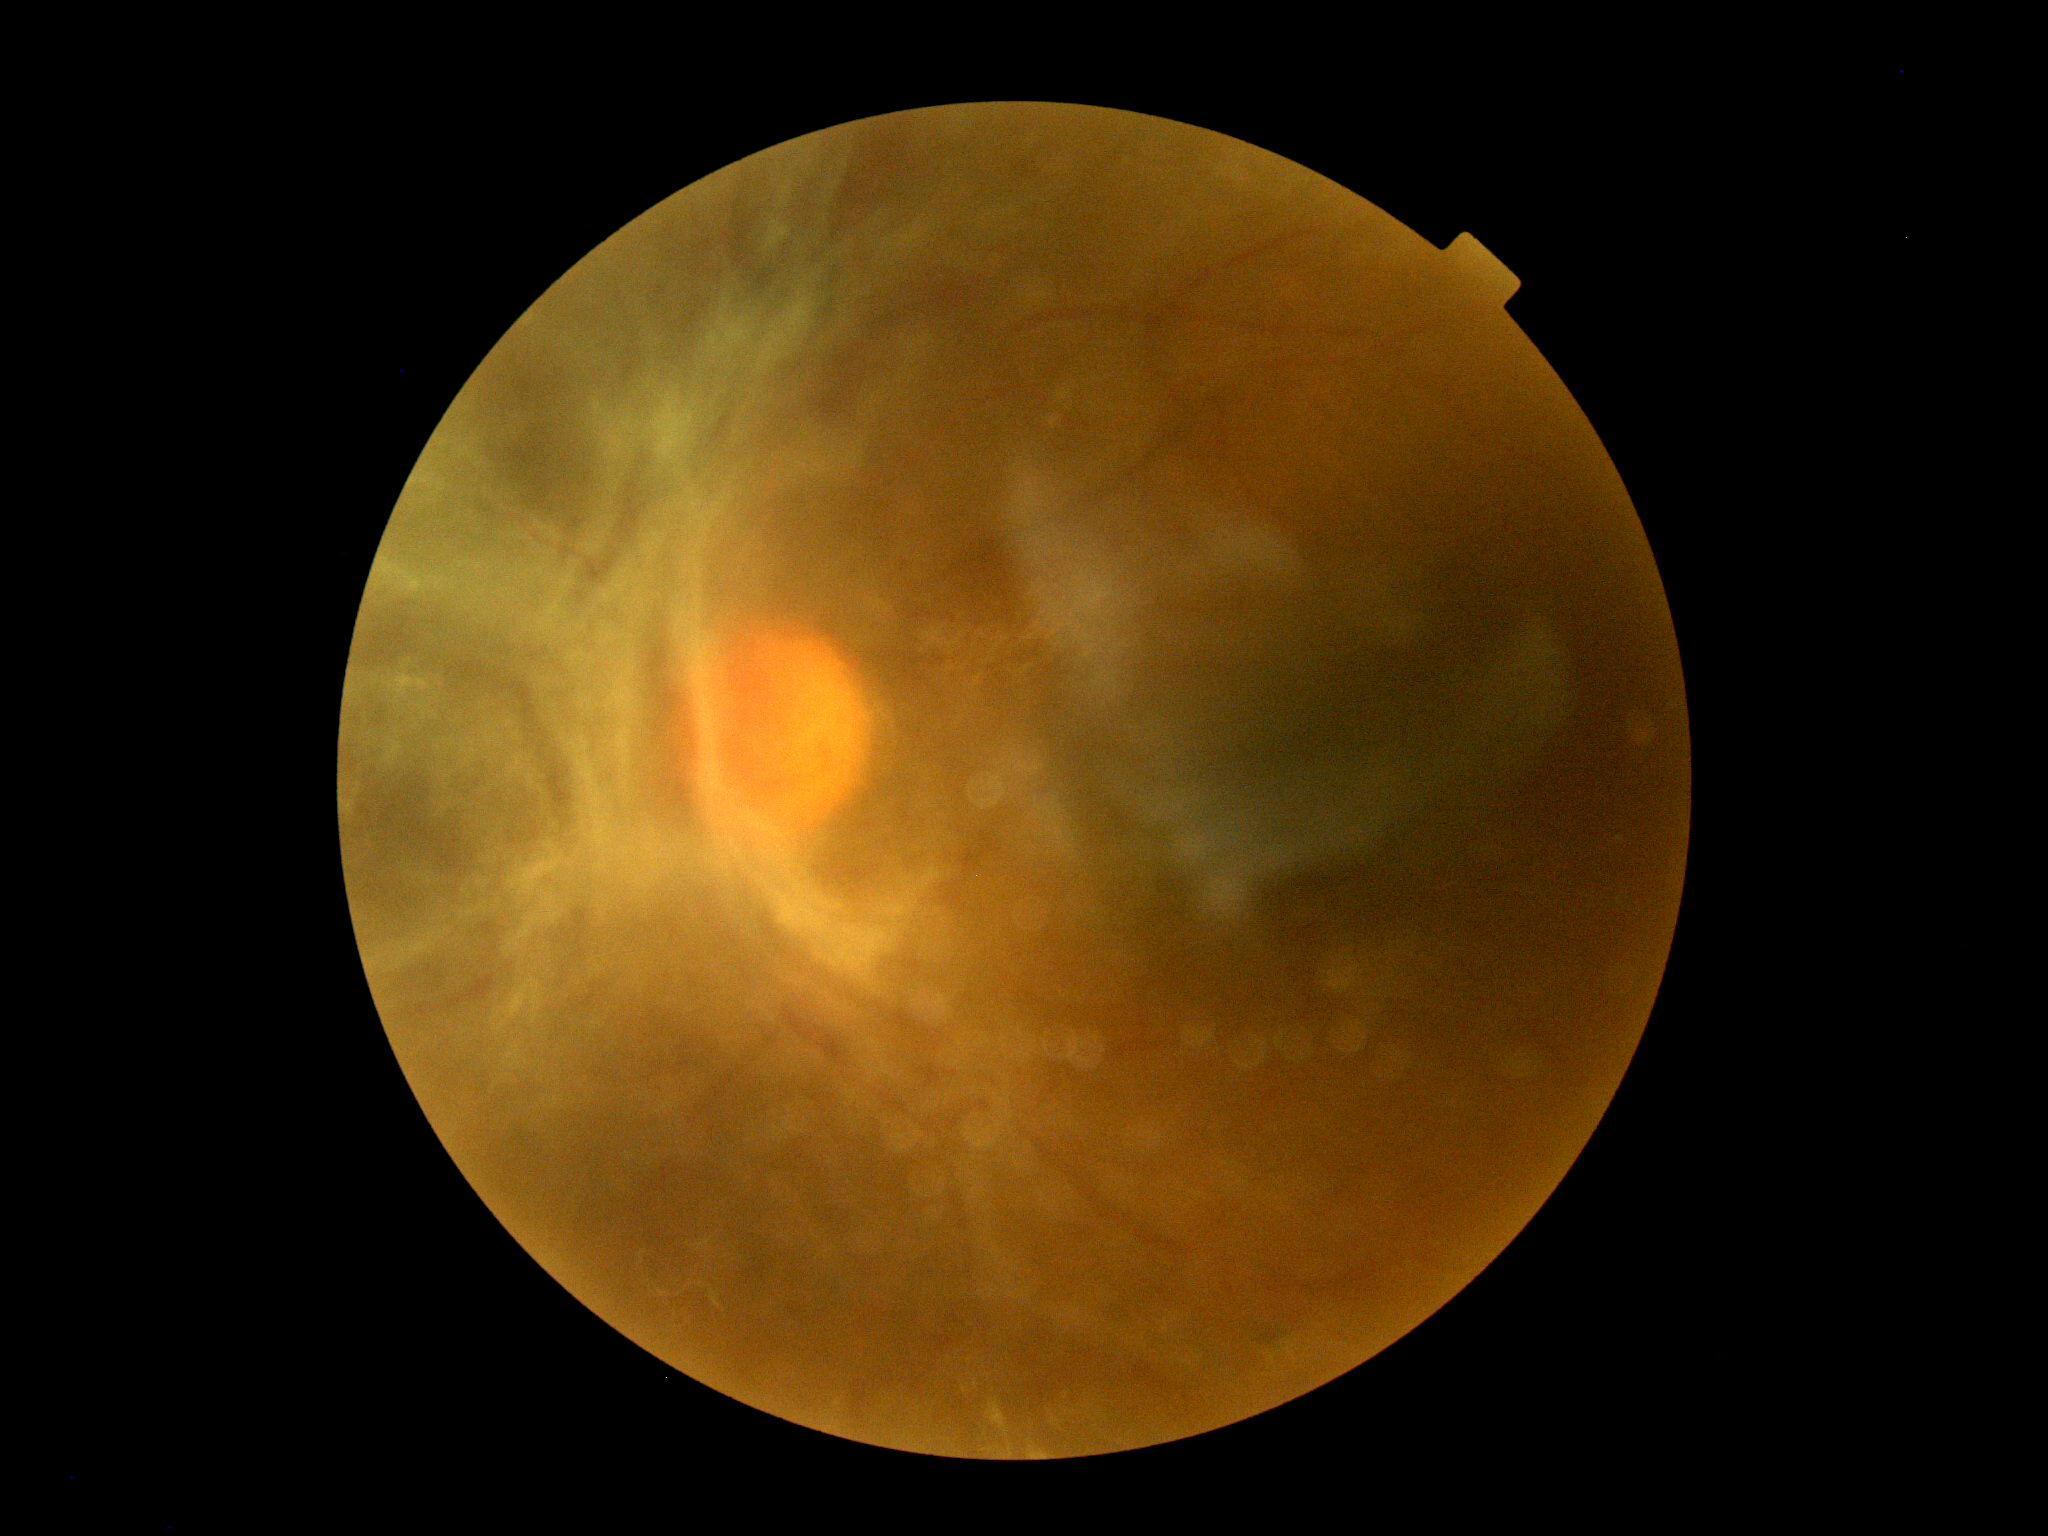 Diabetic retinopathy (DR) is grade 4 (PDR) — neovascularization and/or vitreous/pre-retinal hemorrhage.